Posterior pole photograph. 45° FOV. NIDEK AFC-230 fundus camera. Without pupil dilation. Modified Davis classification — 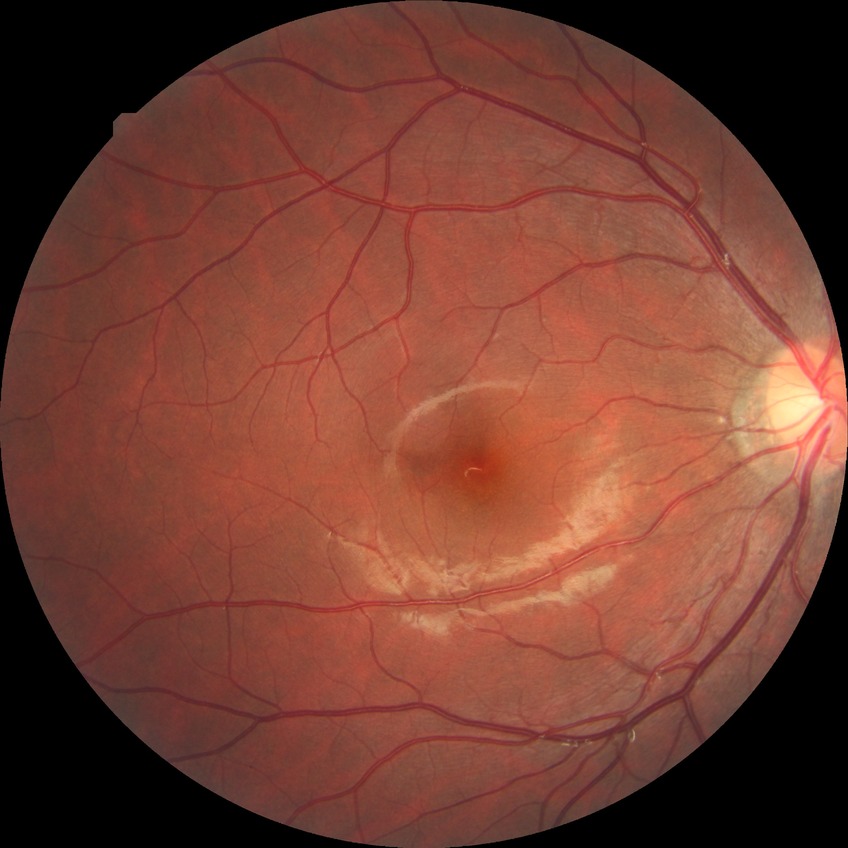

Assessment:
– Davis stage: NDR